Image size 2212x1659: 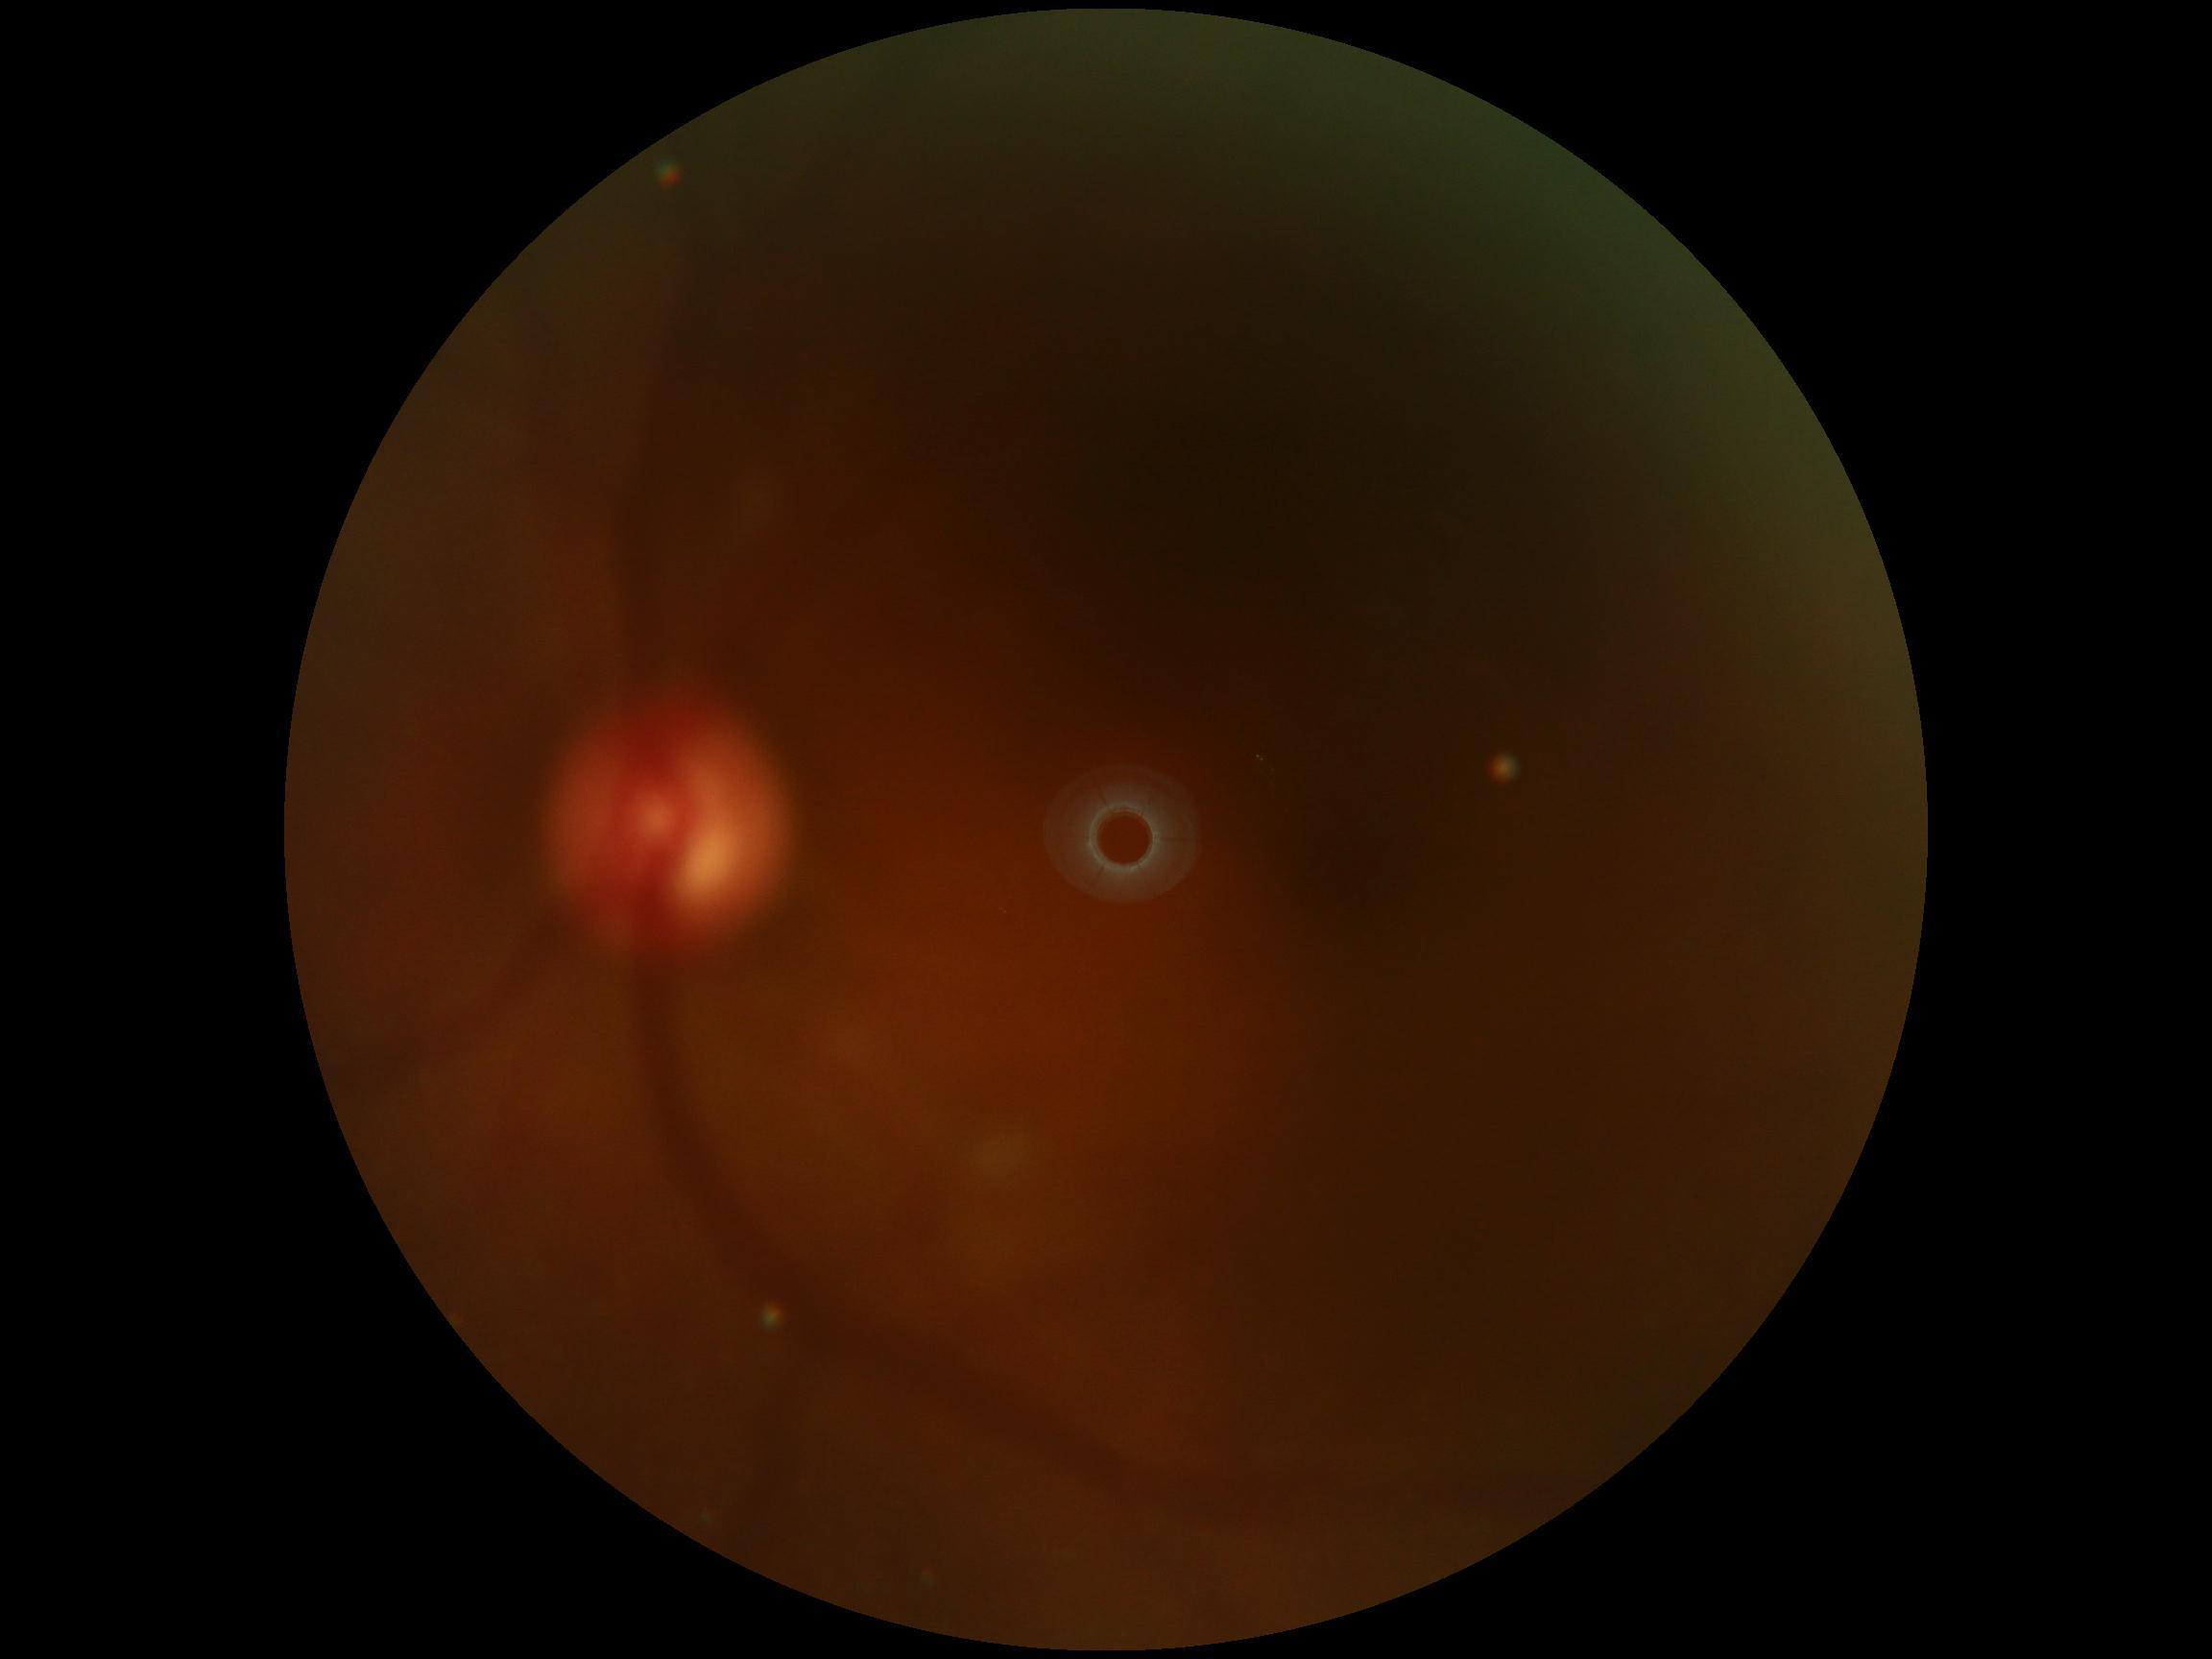

The image cannot be graded for diabetic retinopathy. DR: ungradable.